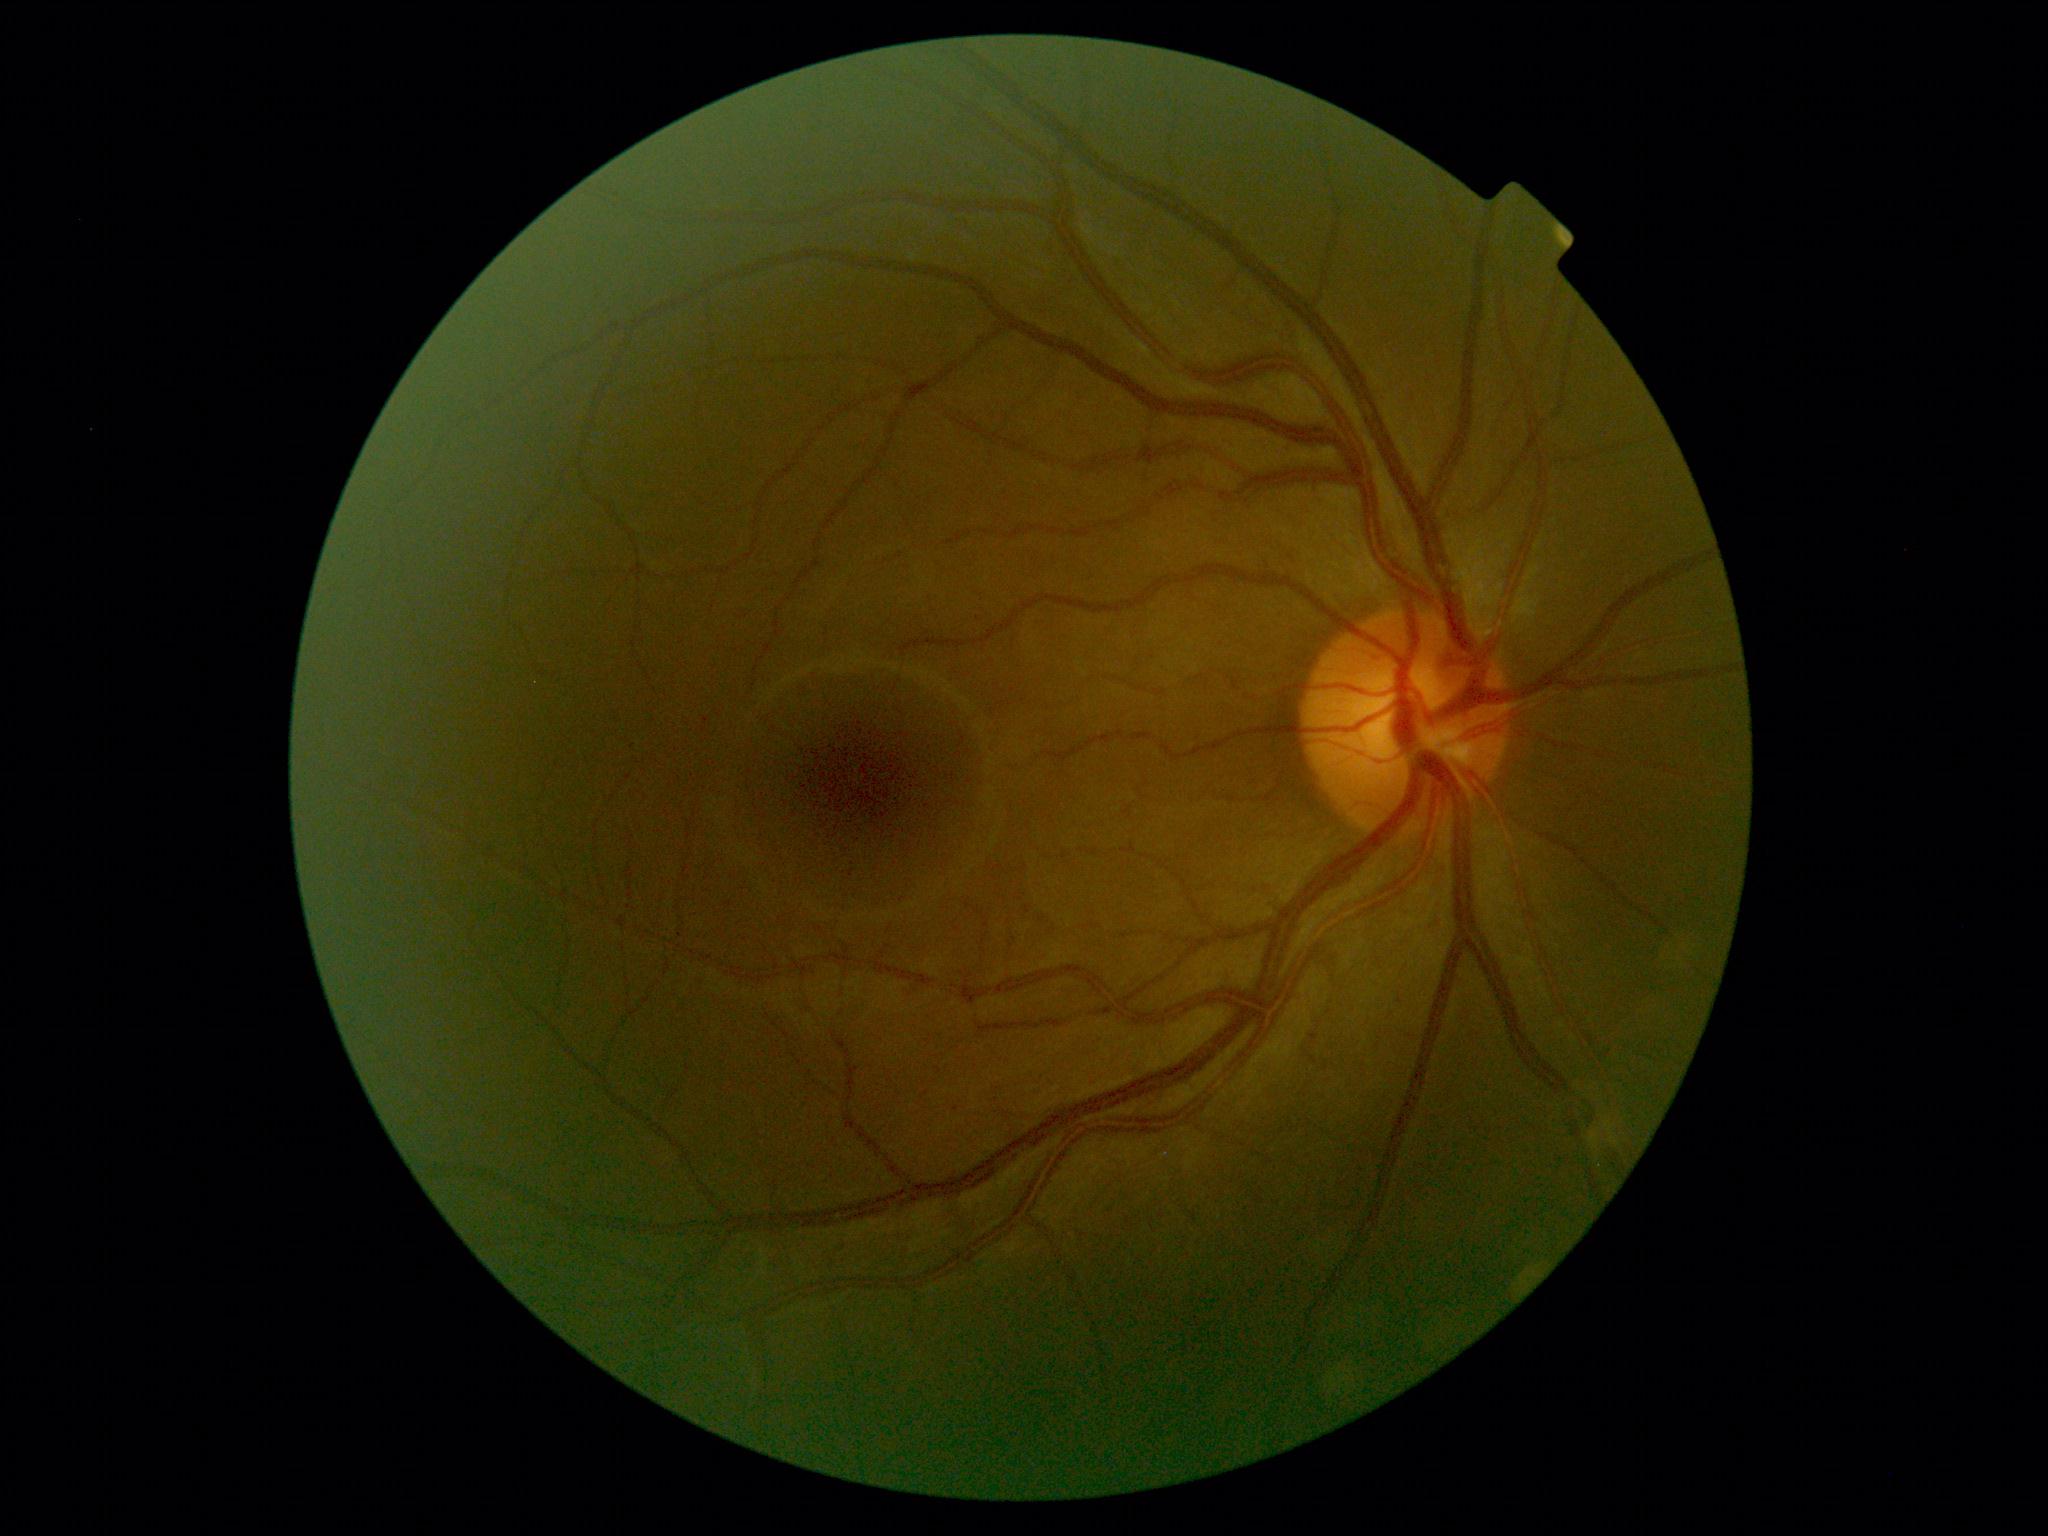

No diabetic retinal disease findings. DR is grade 0 (no apparent retinopathy).